Nidek AFC-330 · non-mydriatic fundus camera
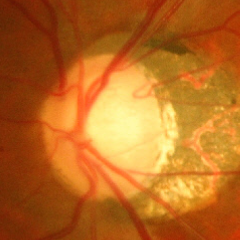 Findings consistent with advanced-stage glaucoma. Diagnostic criteria: near-total cupping of the optic nerve head, with or without severe visual field loss within the central 10 degrees of fixation.